Tabletop color fundus camera image: 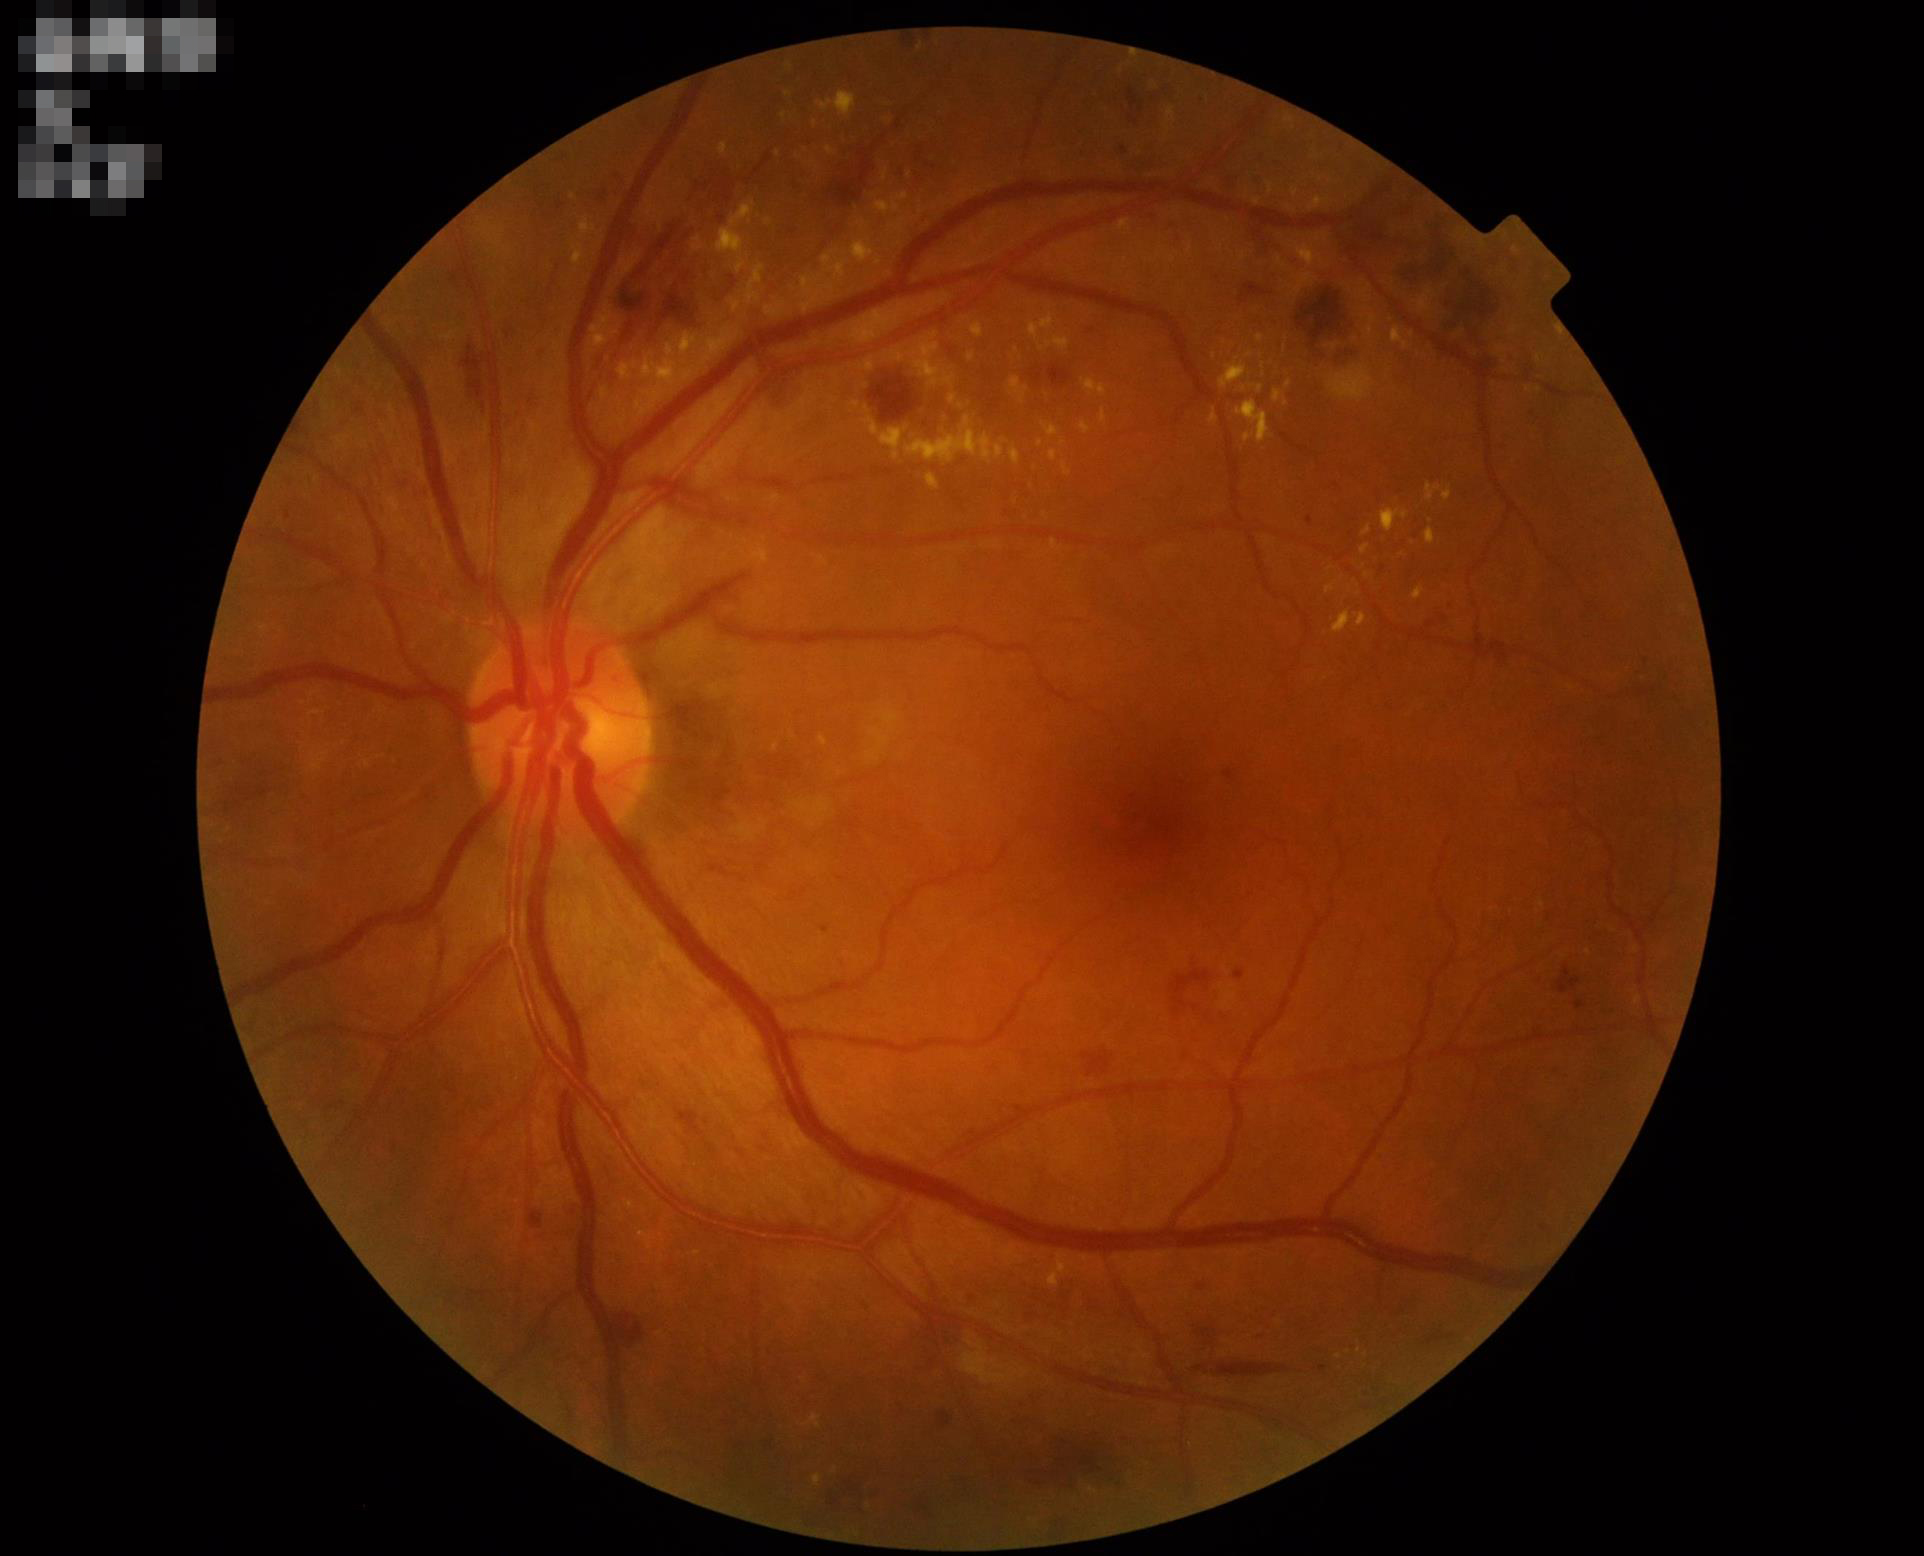
Illumination is even. Contrast is good. Acceptable image quality. Optic disc, vessels, and background are in focus.